CFP: 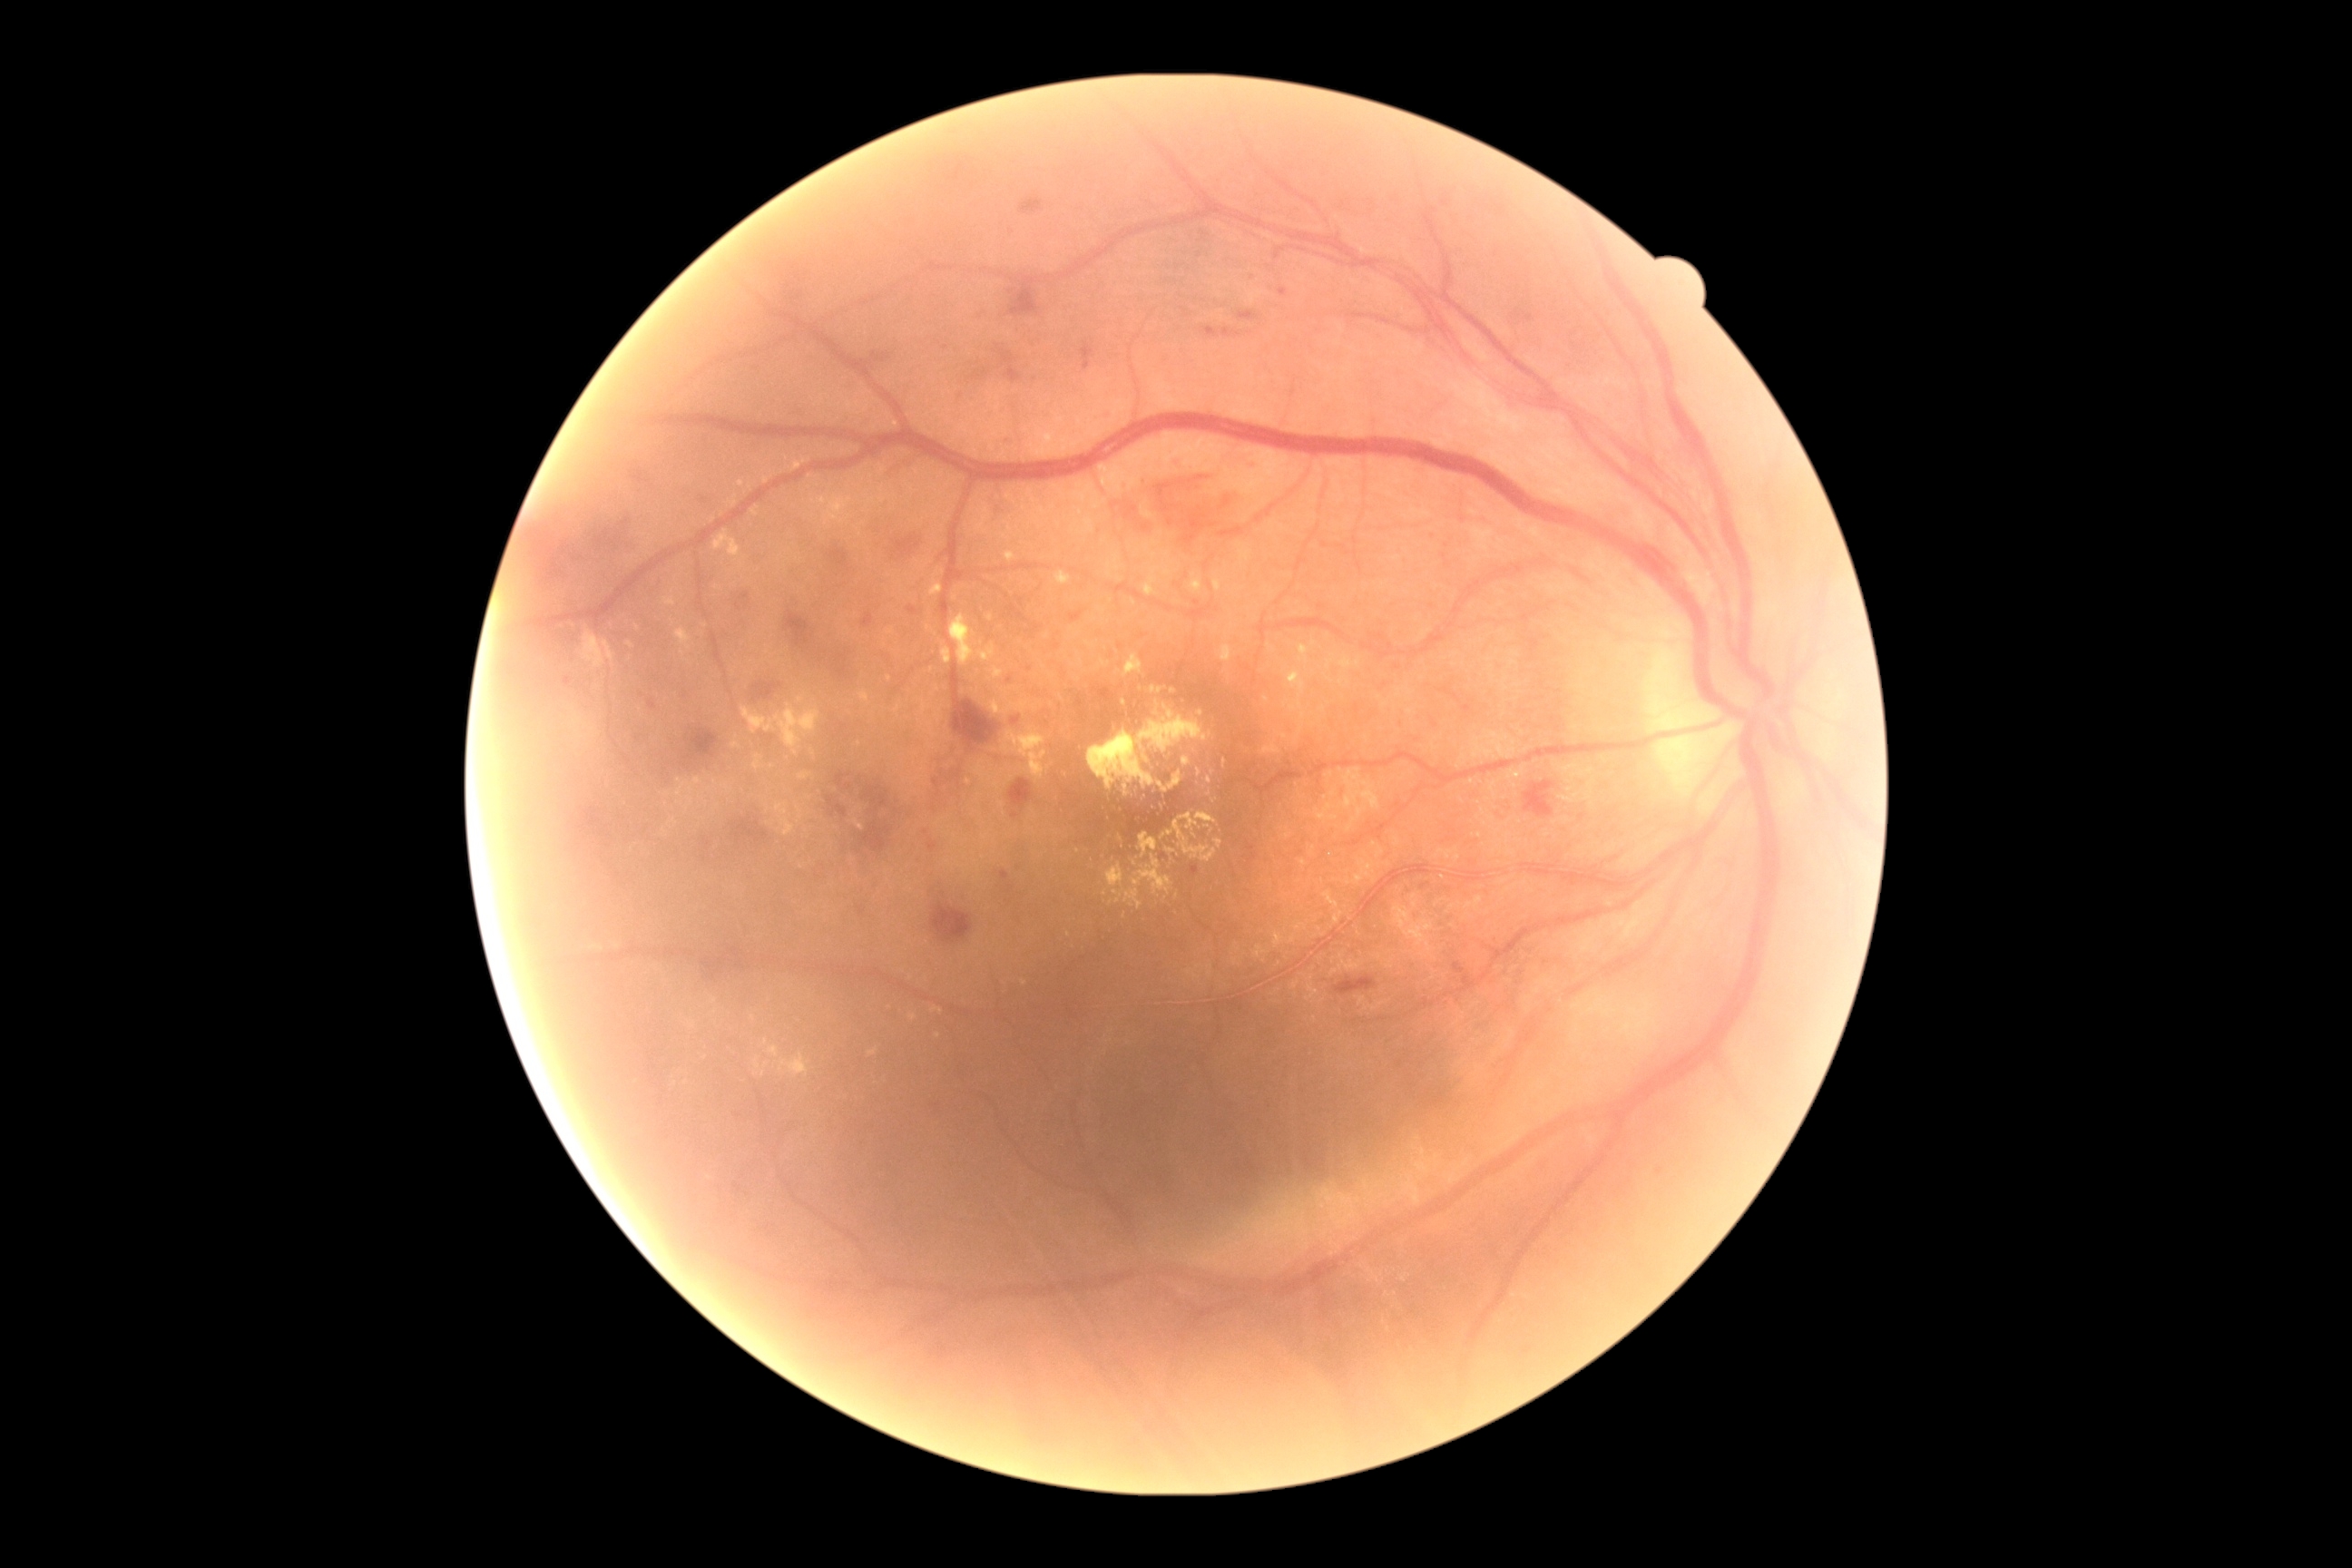 DR grade is 2 (moderate NPDR)
A subset of detected lesions:
EXs (continued): [798,772,810,781] | [774,803,796,838] | [988,614,994,622] | [1182,758,1191,767] | [943,649,952,665] | [1104,785,1166,821] | [1298,645,1309,663] | [1340,658,1362,671] | [932,1008,943,1014] | [1288,671,1306,698] | [729,502,738,507]
Small EXs near x=1213 y=772 | x=1070 y=934 | x=679 y=803 | x=1125 y=702 | x=716 y=782 | x=919 y=779 | x=715 y=1001